Image size 2352x1568; color fundus image — 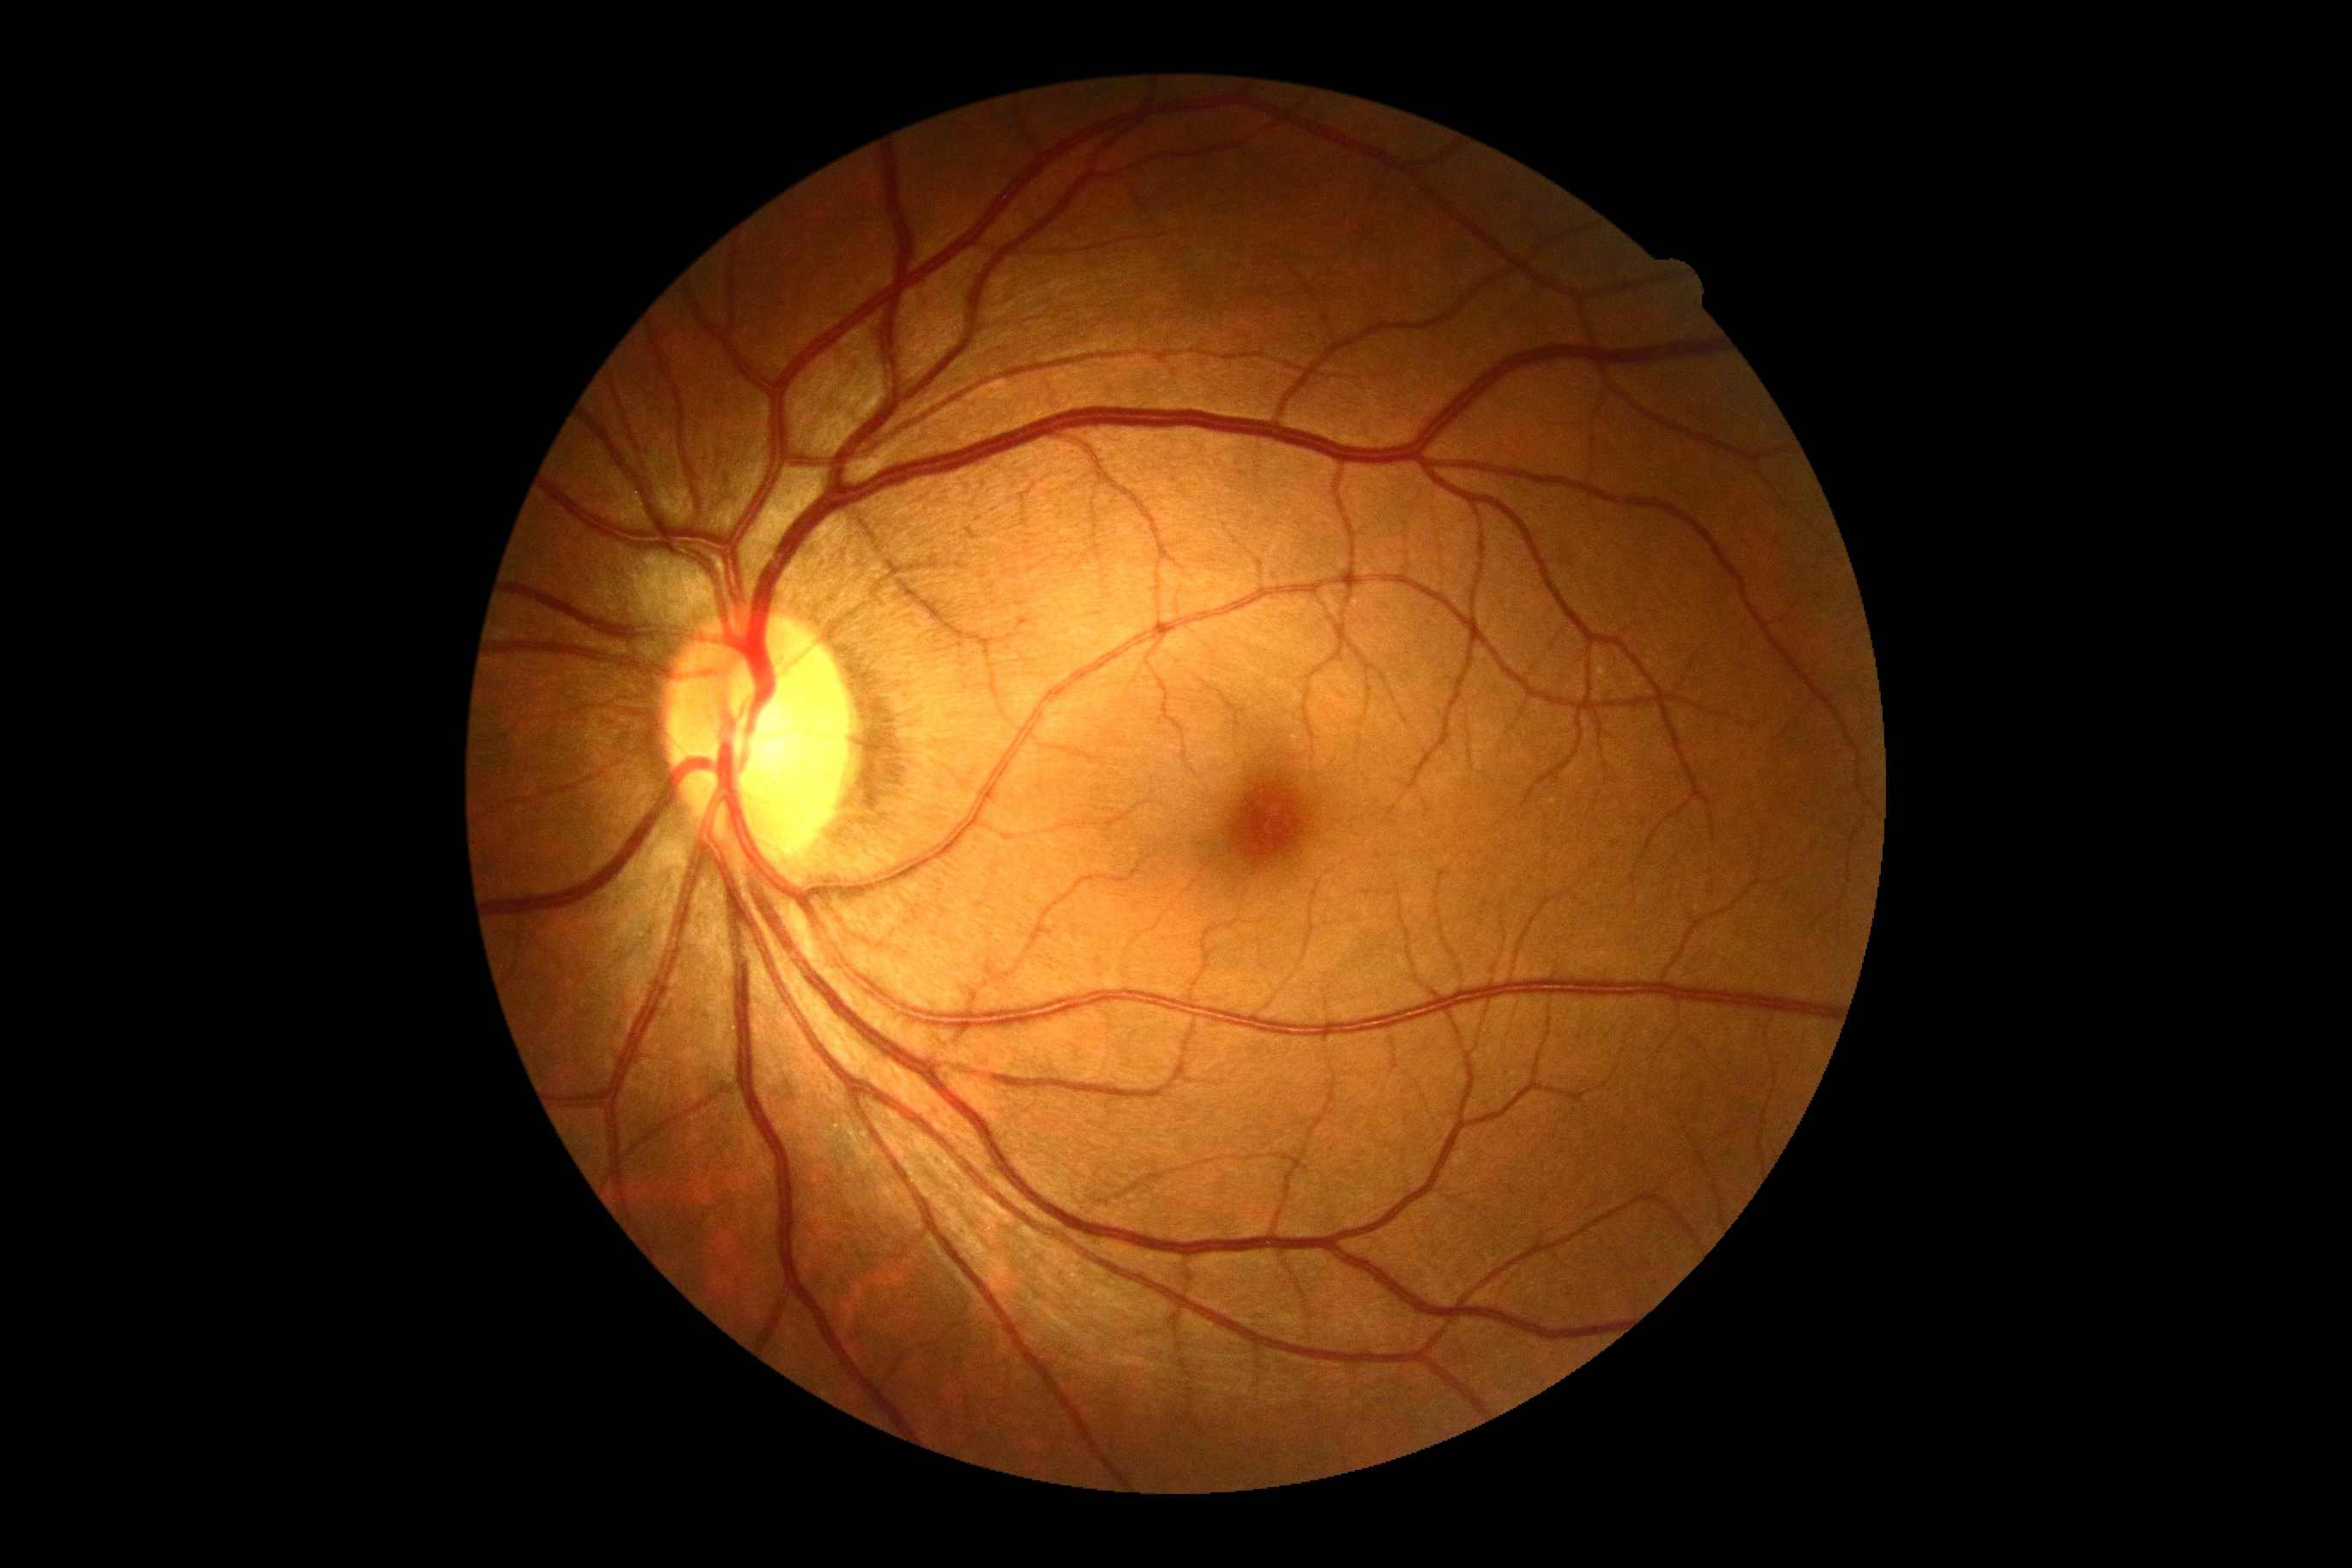 Diabetic retinopathy (DR): no apparent retinopathy (grade 0).